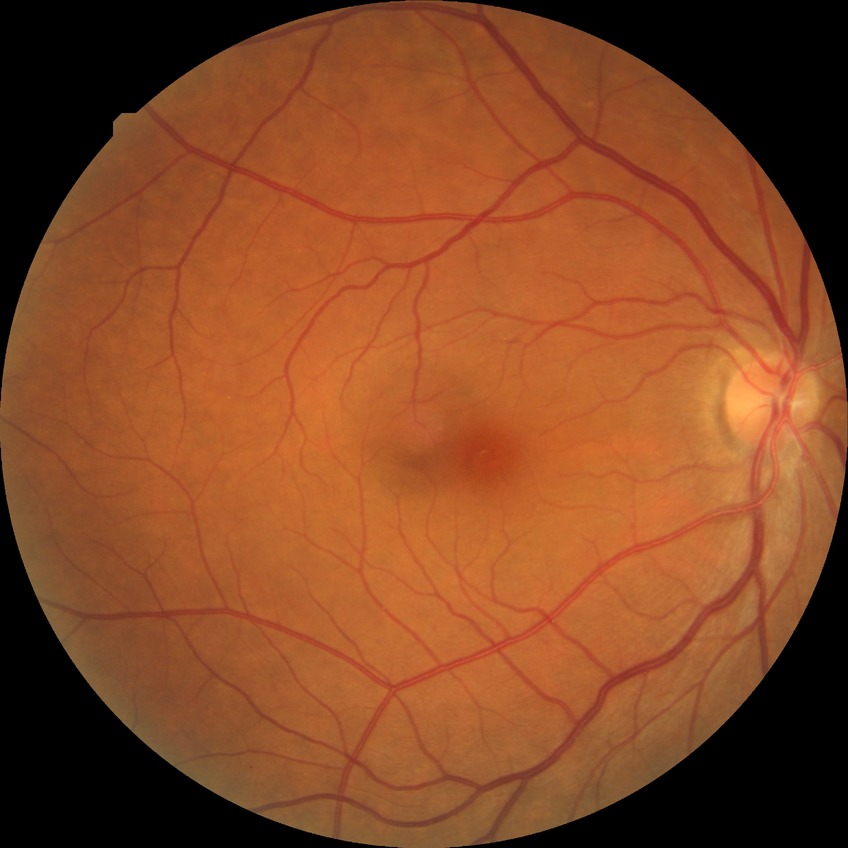 Diabetic retinopathy (DR) is no diabetic retinopathy (NDR).